Infant wide-field retinal image · camera: Phoenix ICON (100° FOV):
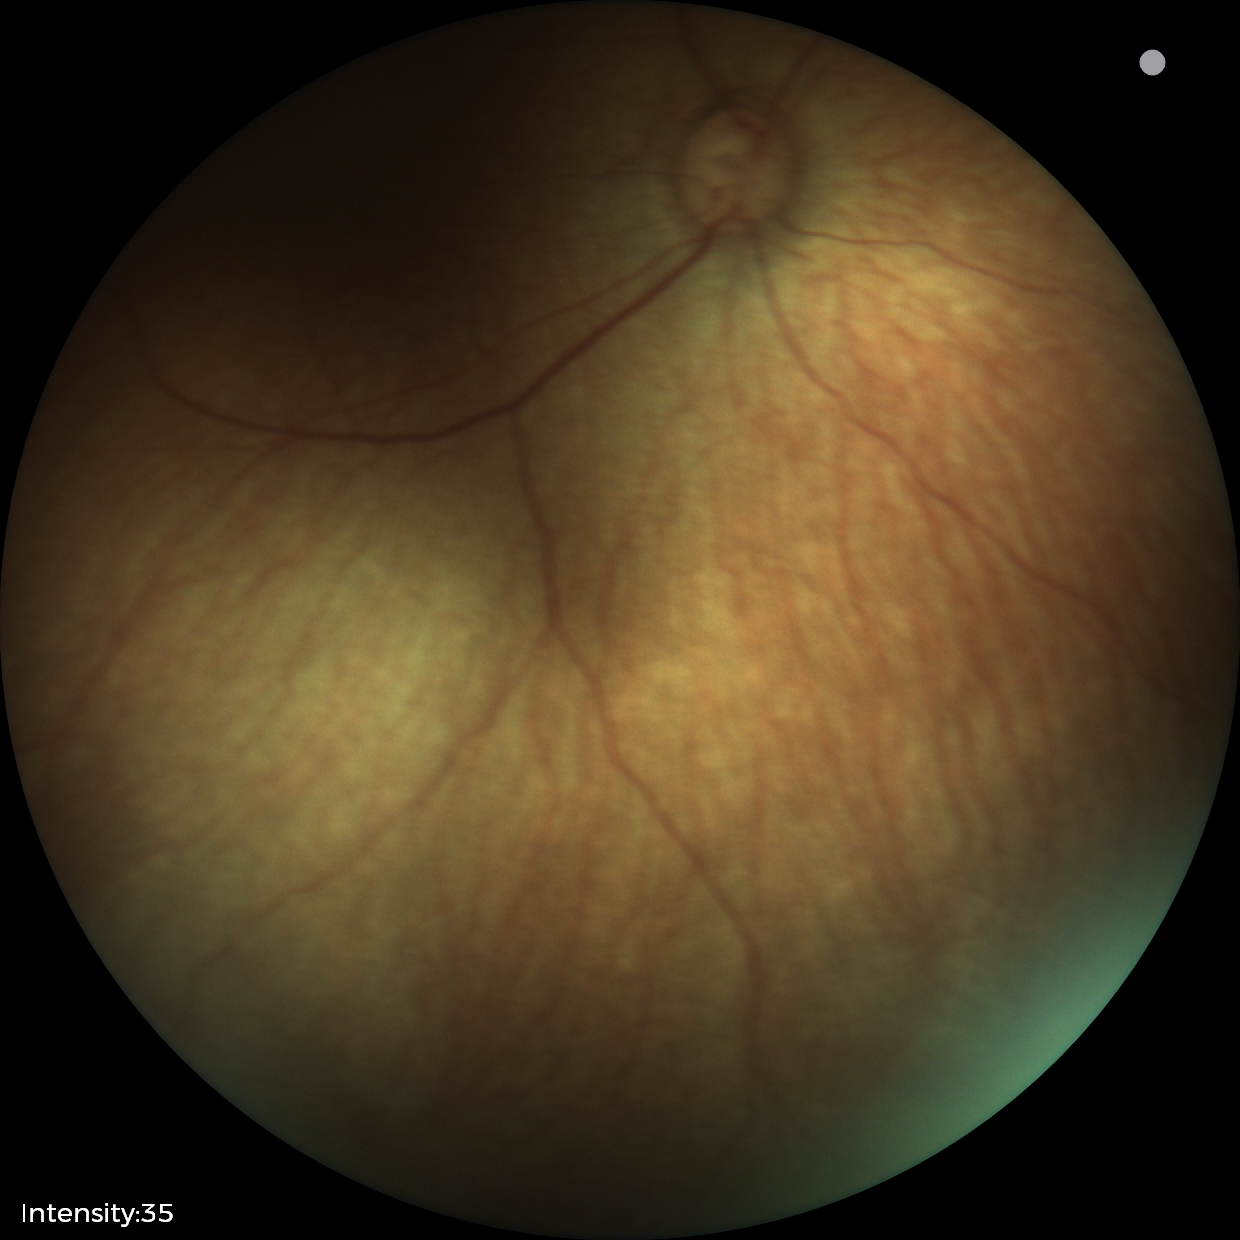 Screening examination with no abnormal retinal findings.